CFP.
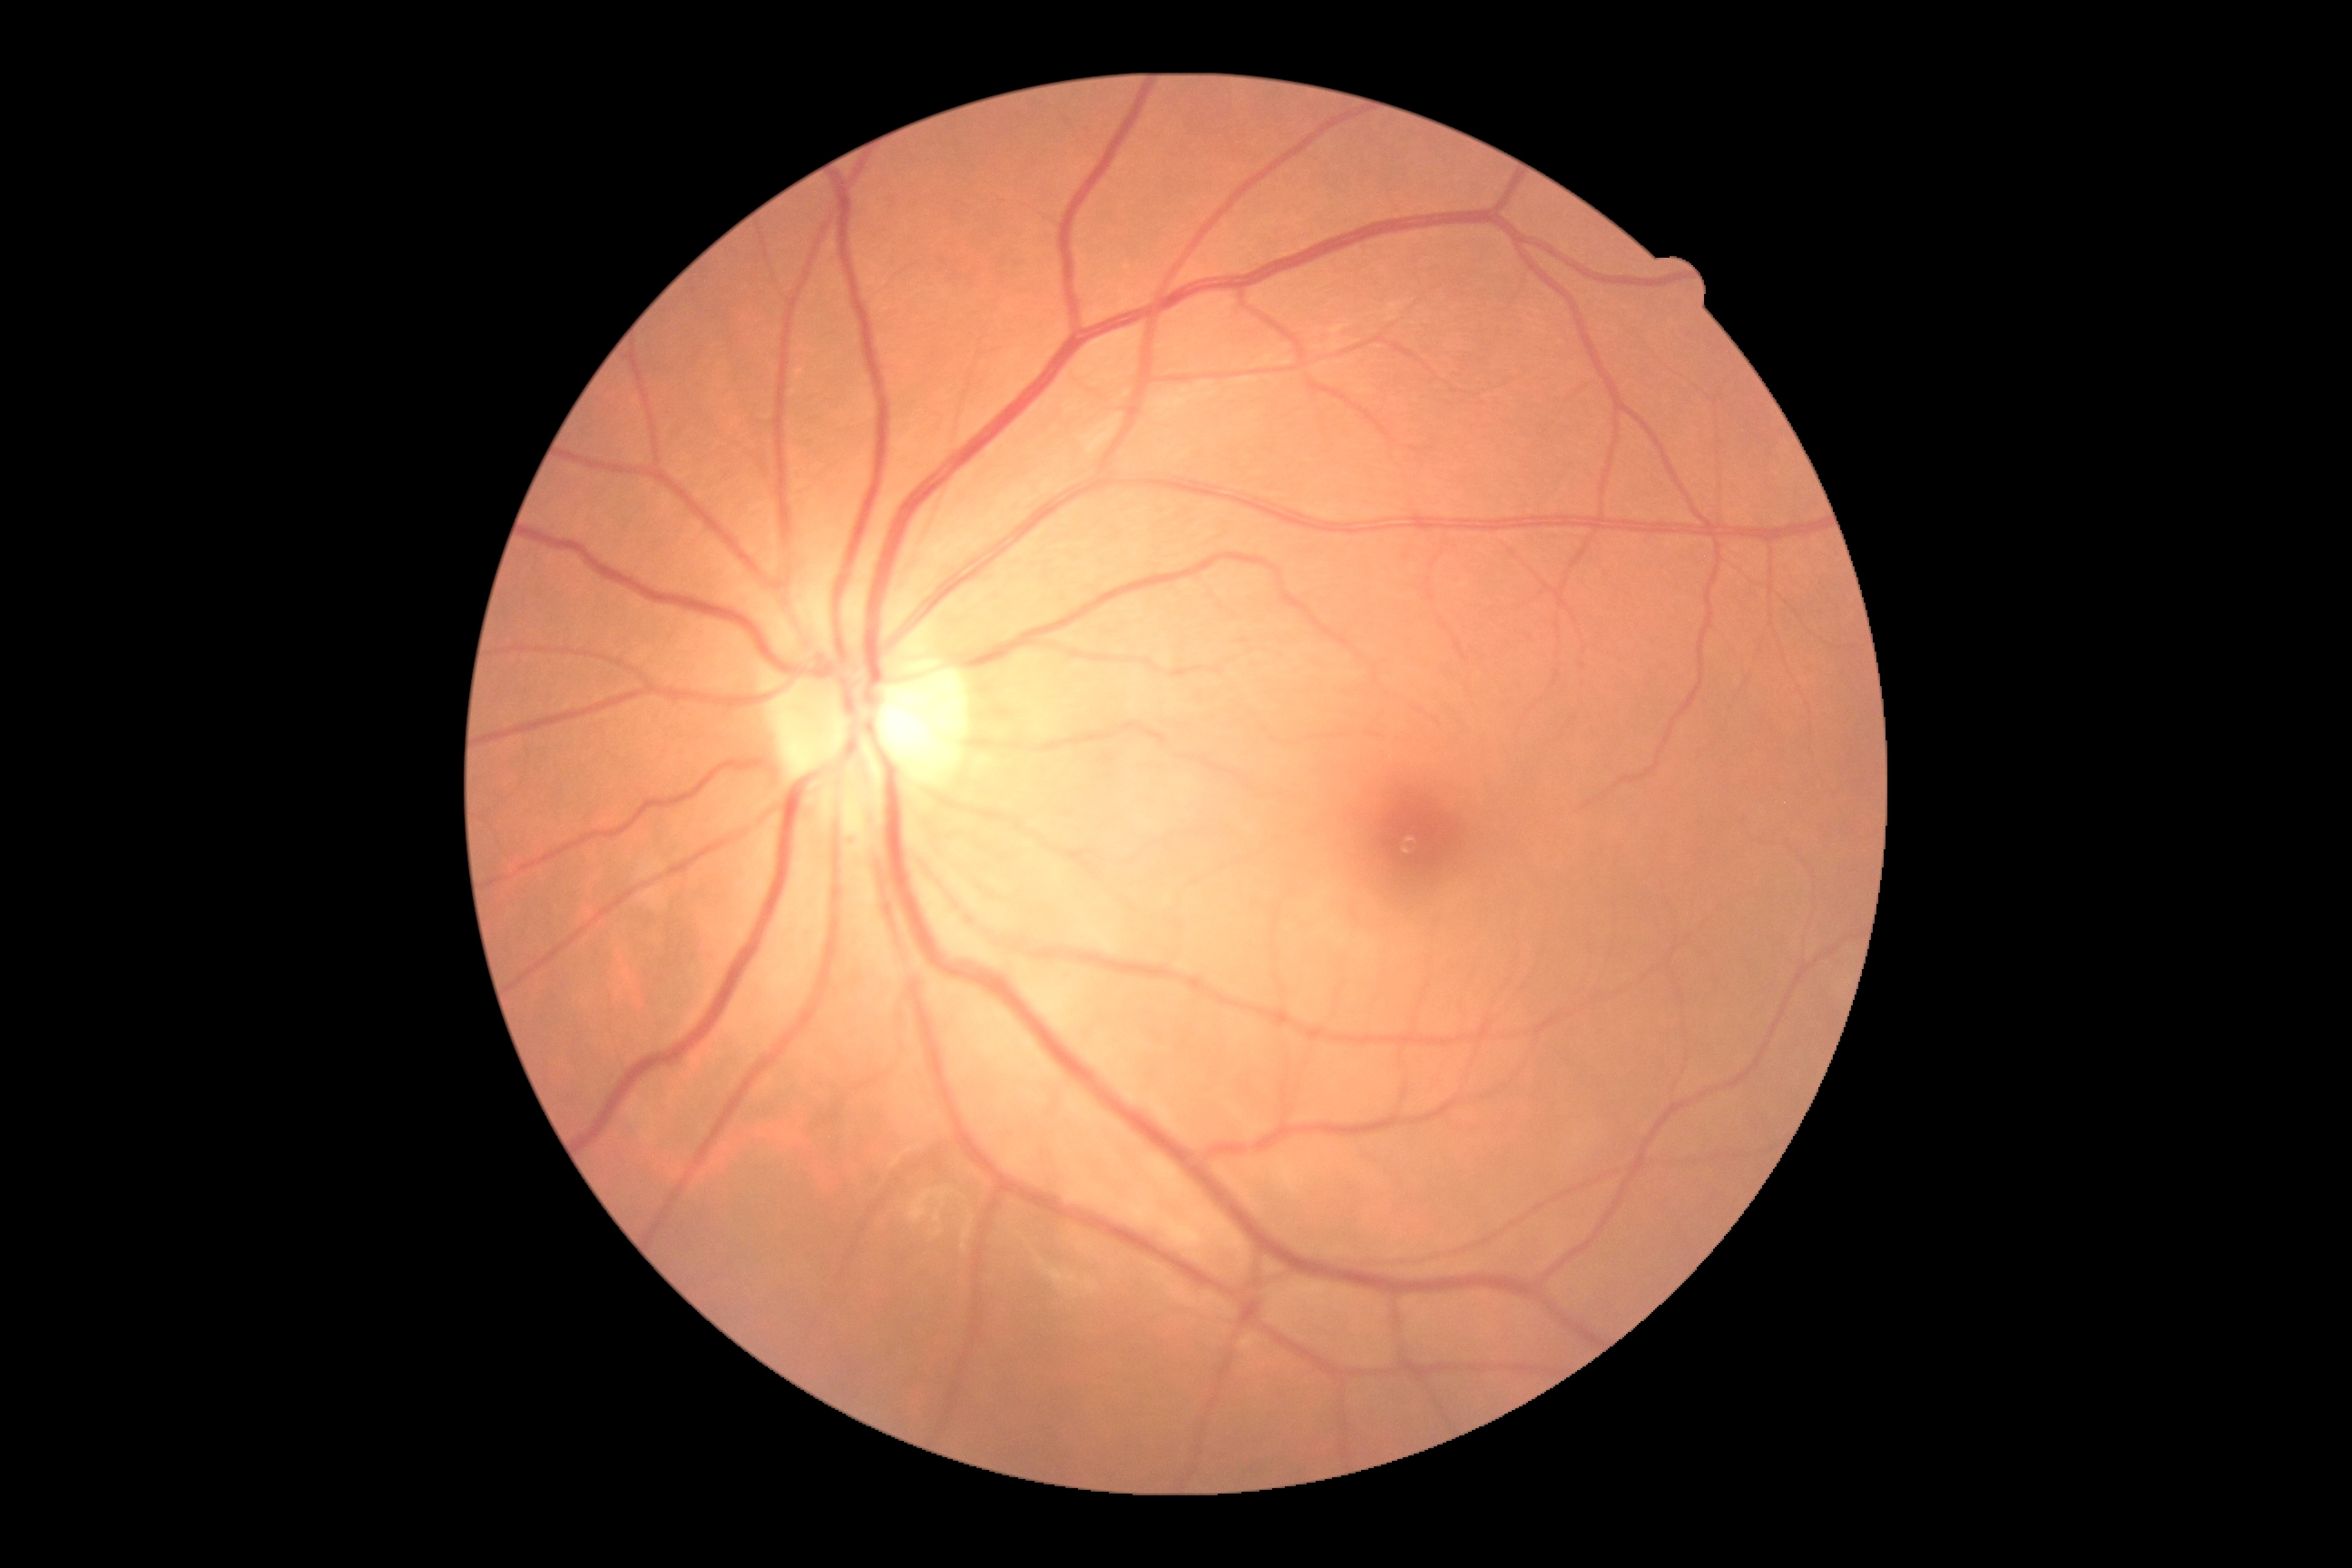
DR stage is no apparent retinopathy (grade 0).